Color fundus image:
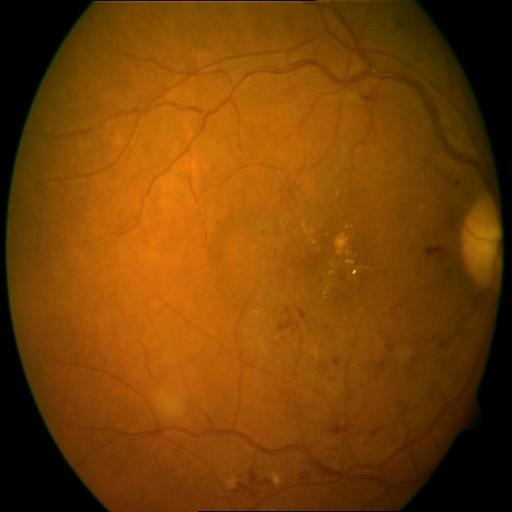

2 findings. There is evidence of cystoid macular edema (CME) & hemorrhagic retinopathy (HR).